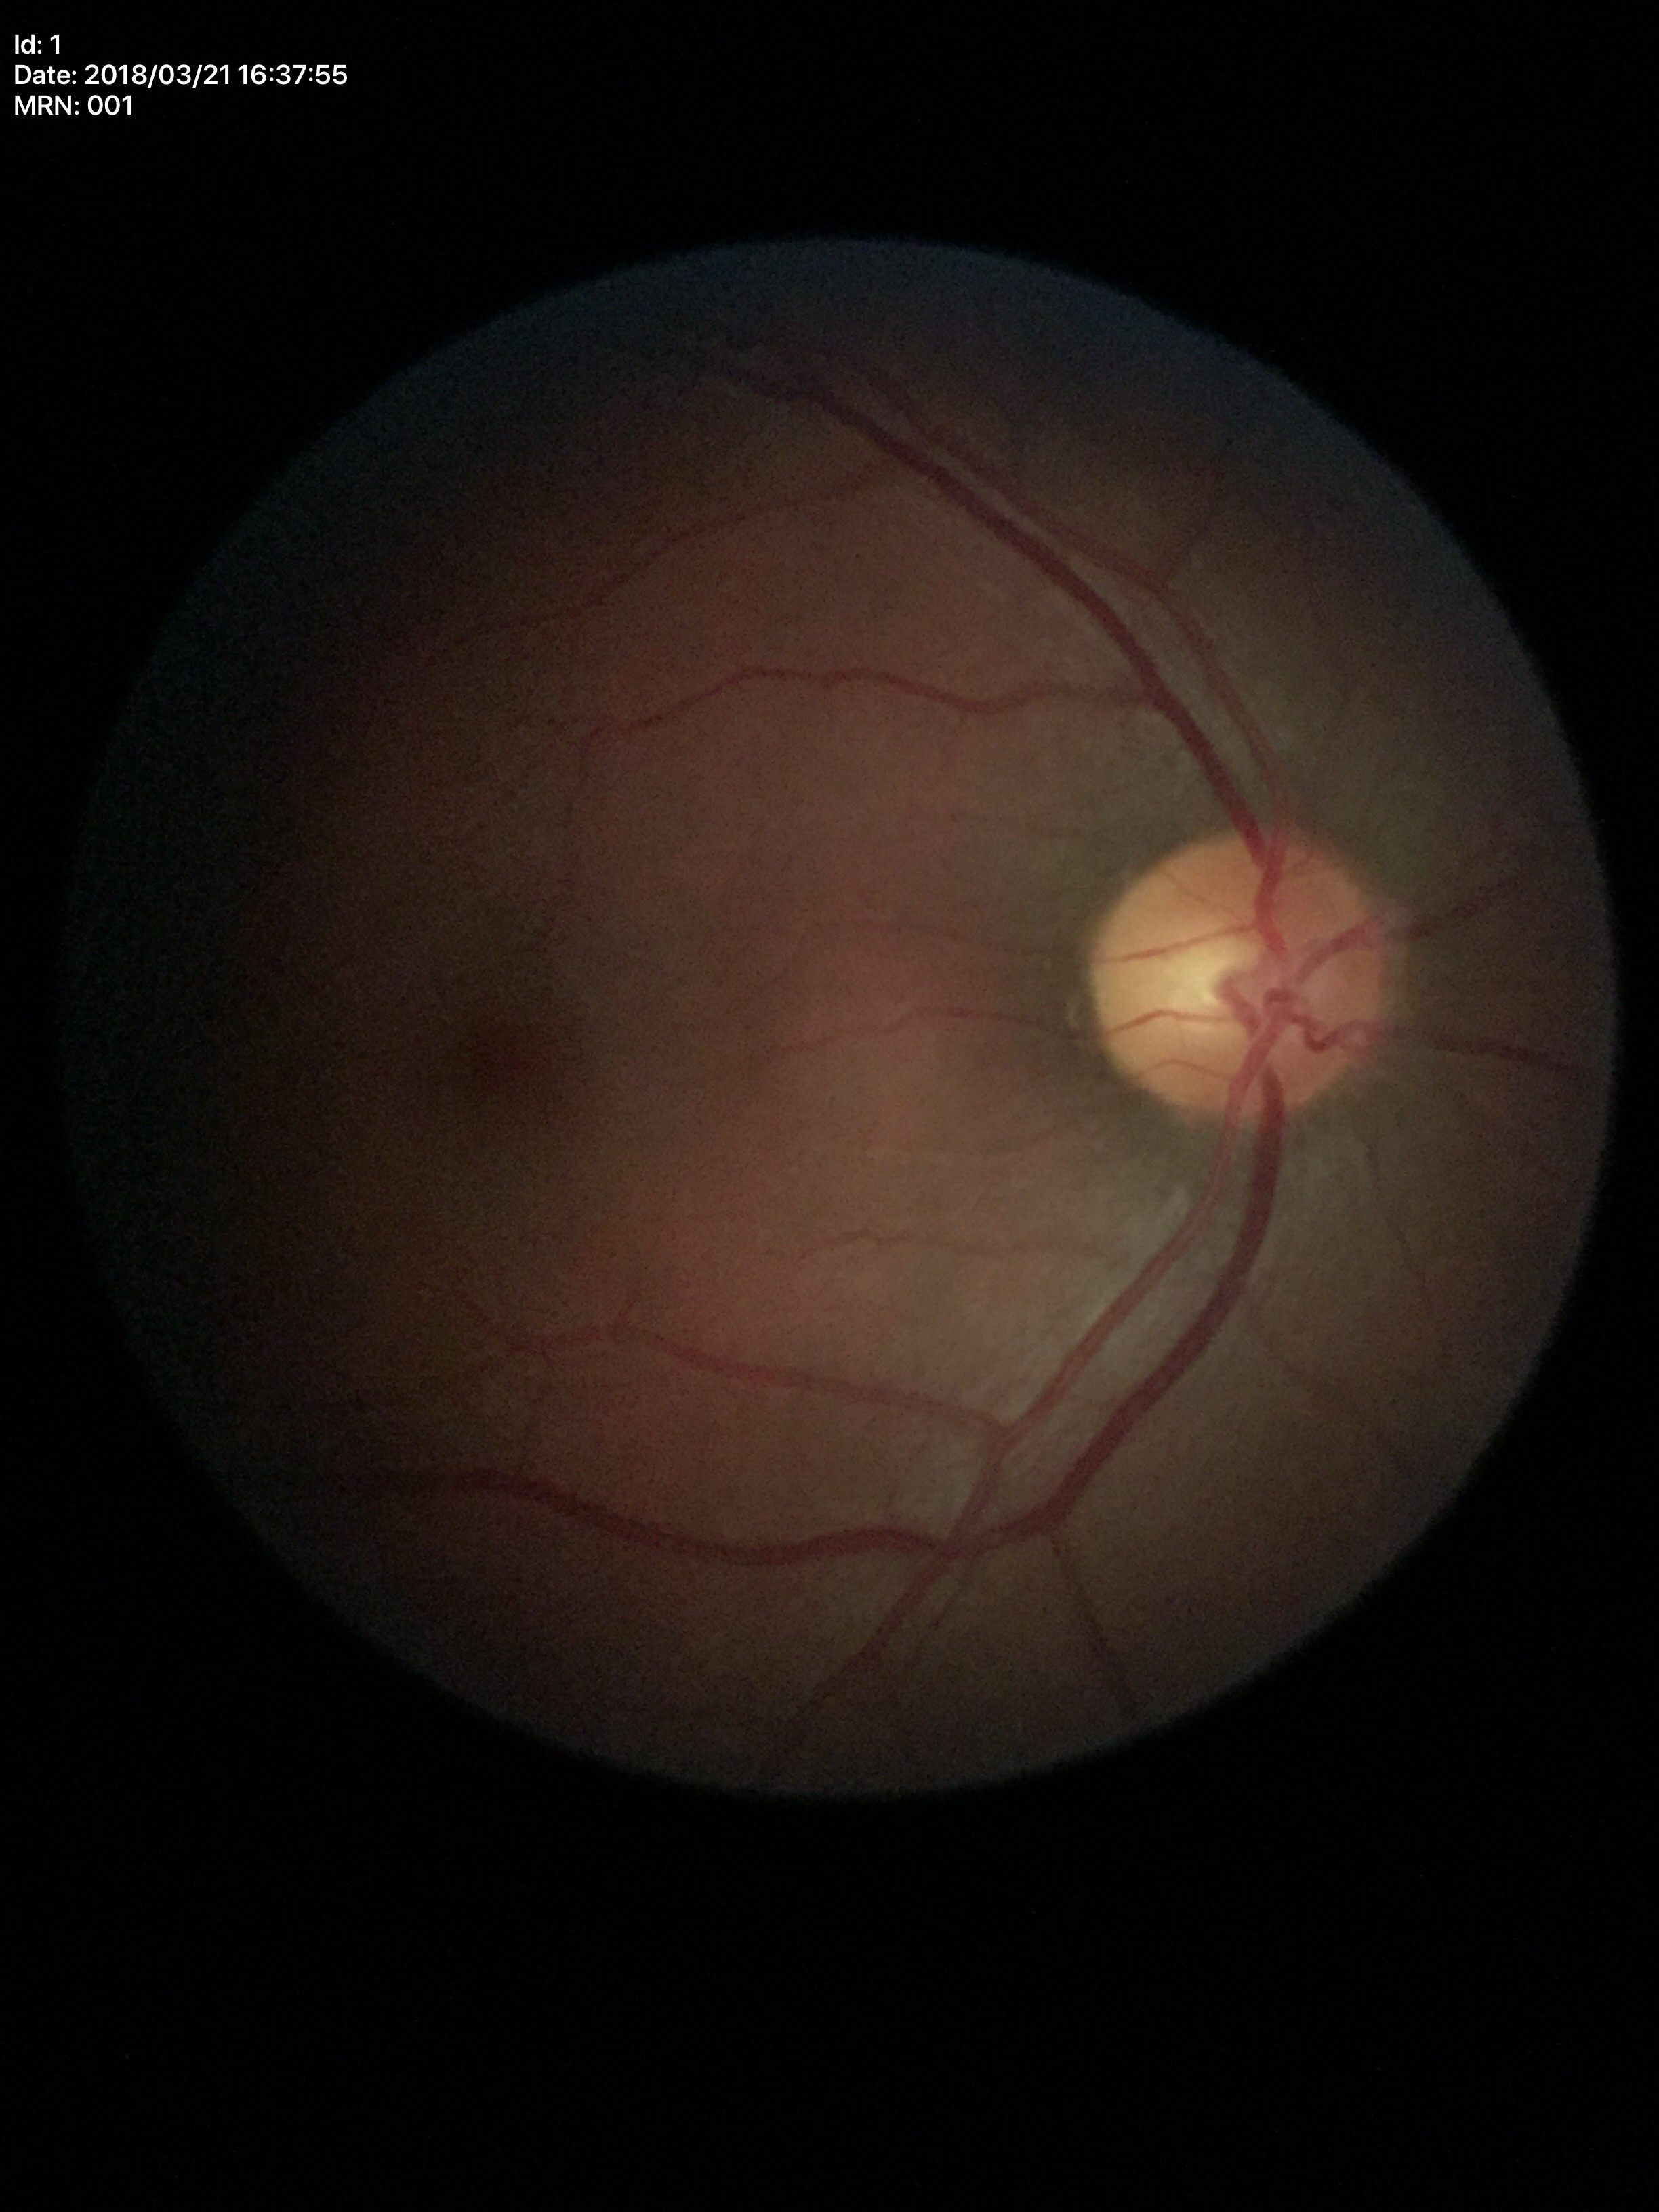

- Glaucoma evaluation · negative
- vertical C/D ratio · 0.49
- horizontal CDR · 0.52